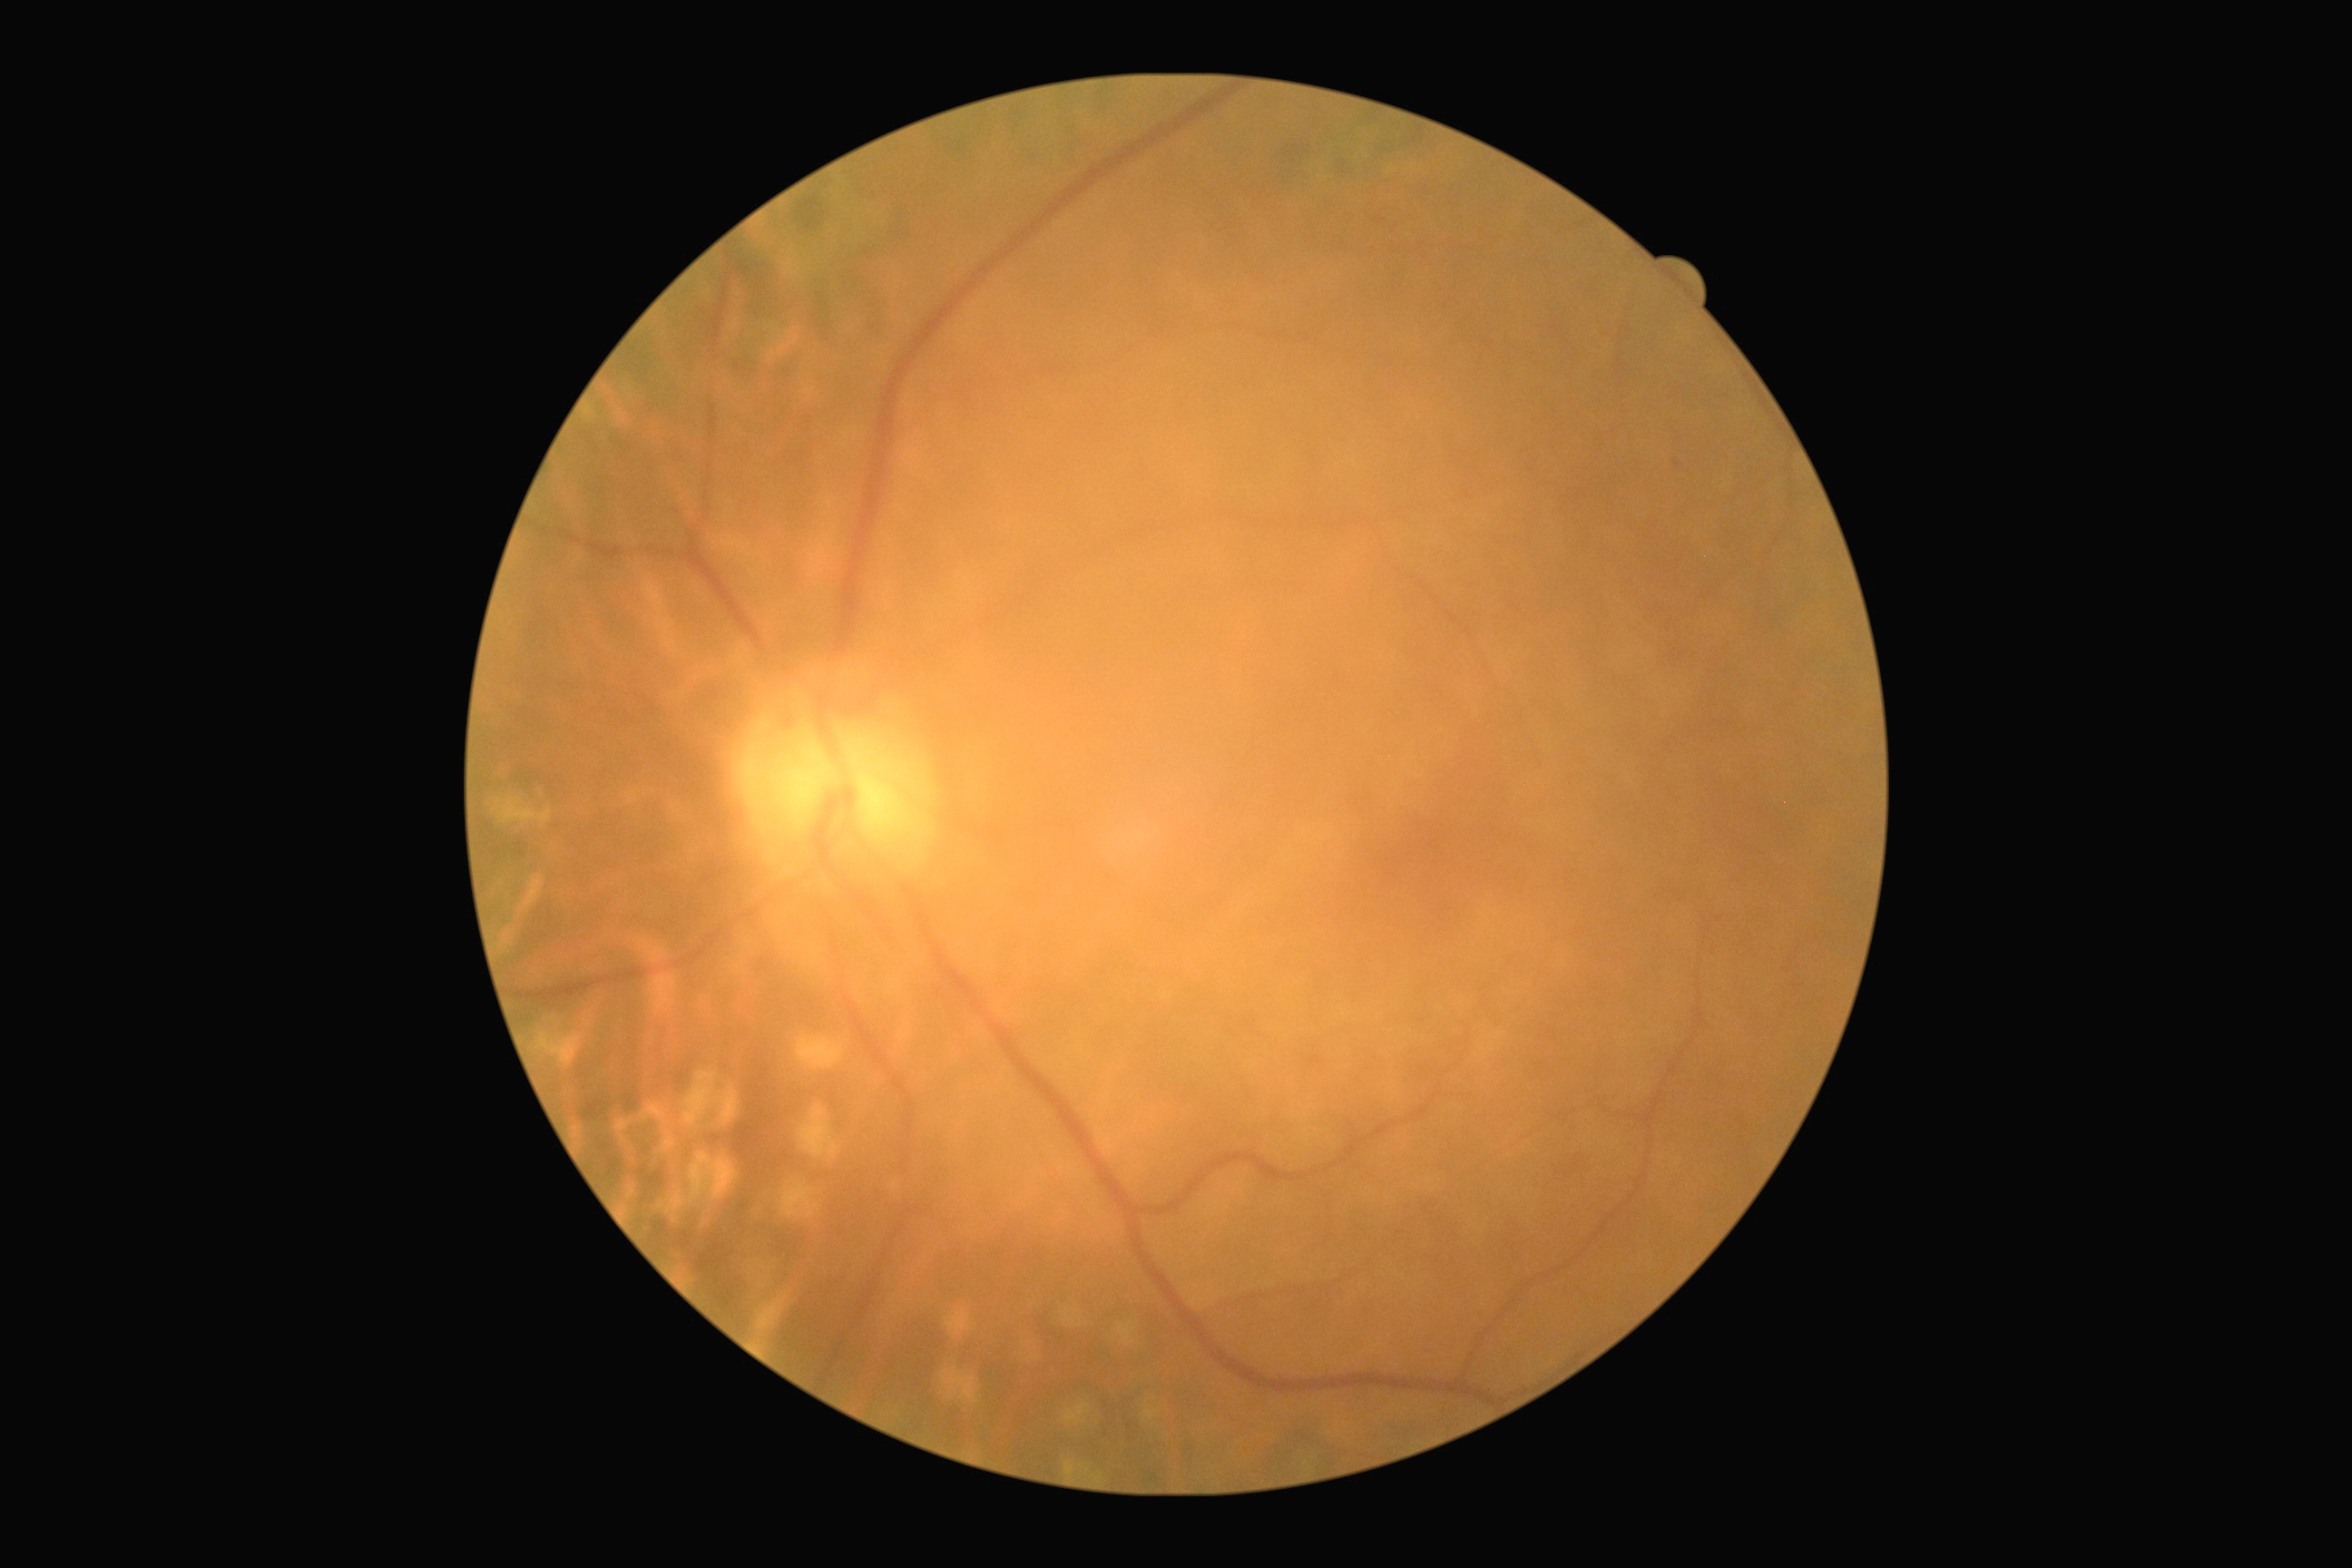

Disease class: non-proliferative diabetic retinopathy.
Diabetic retinopathy: grade 1 (mild NPDR).